Wide-field contact fundus photograph of an infant · Natus RetCam Envision, 130° FOV — 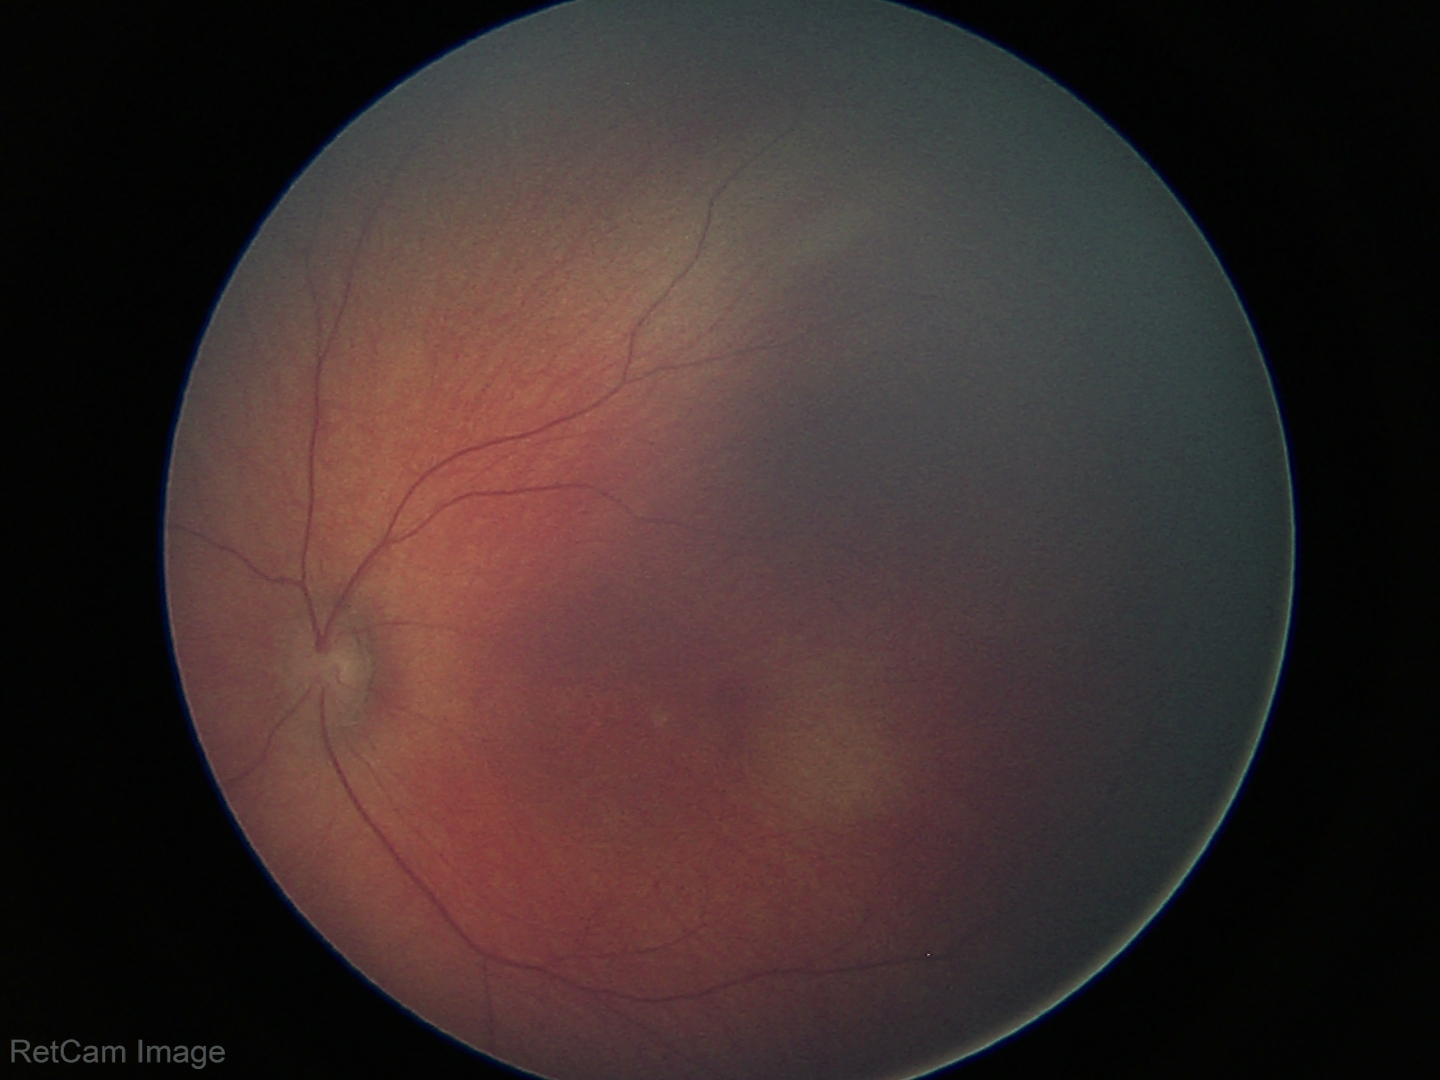
Screening examination with no abnormal retinal findings.